Axial length (AL): 23 mm: 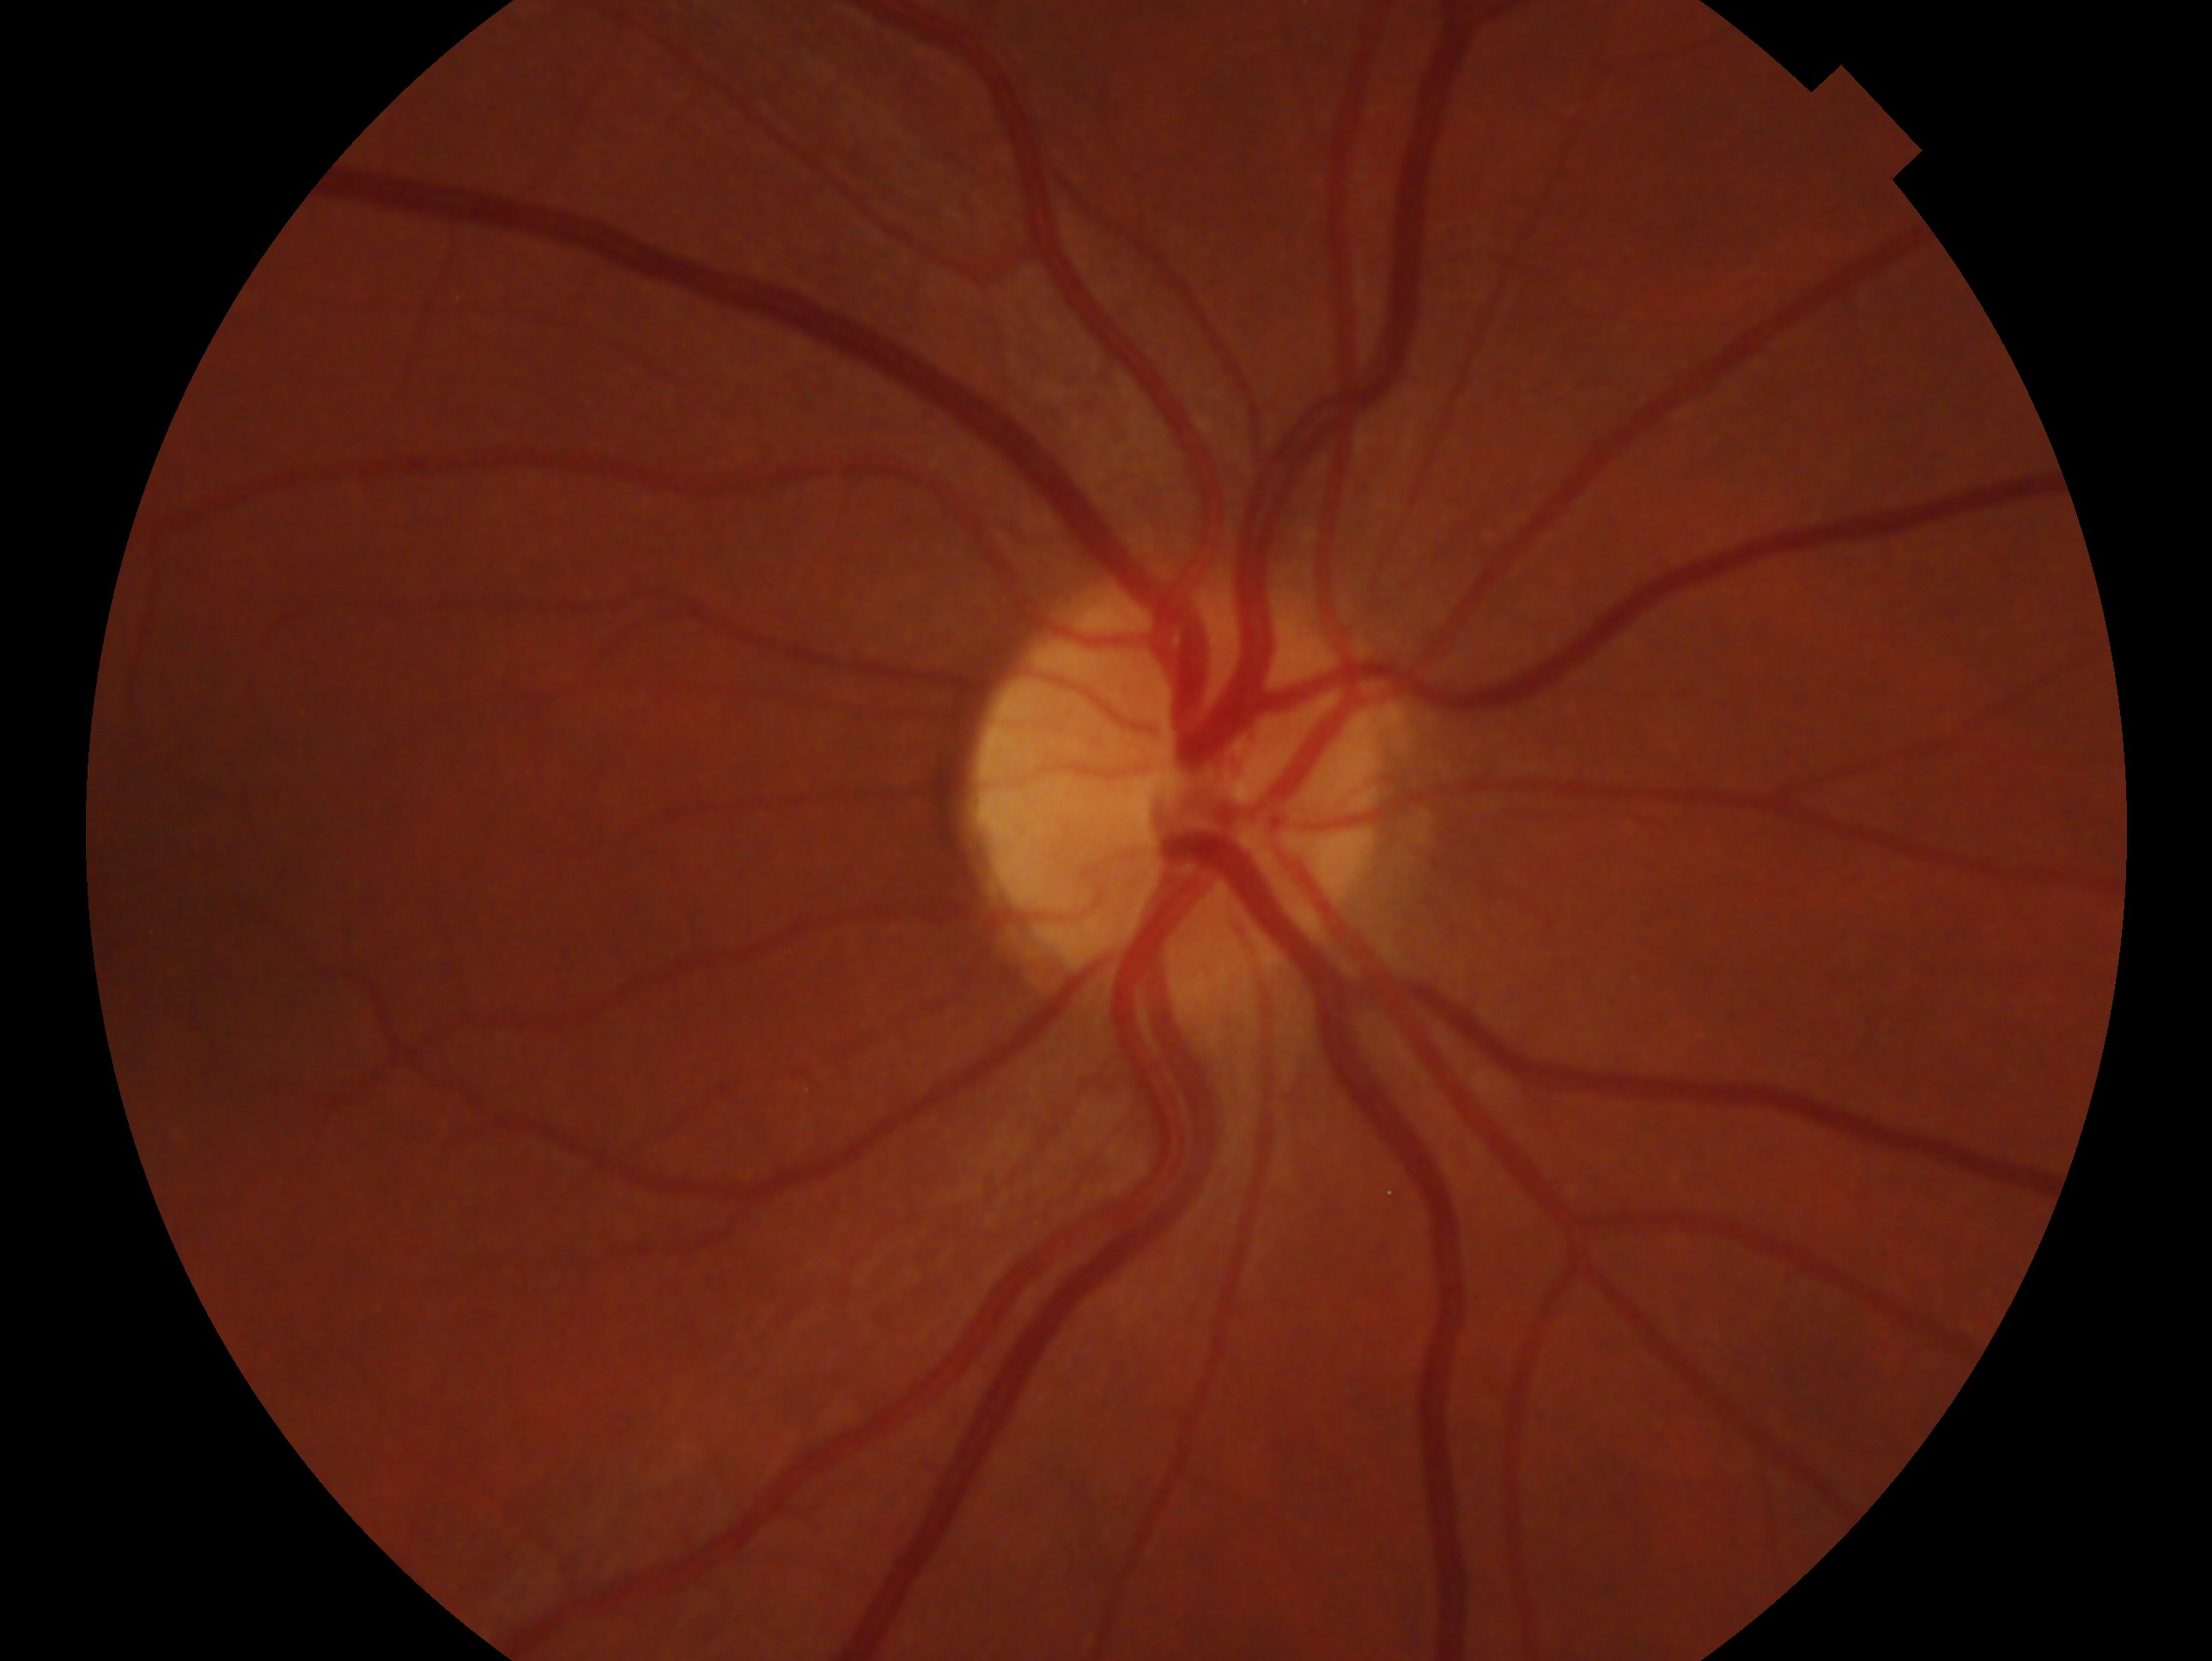
impression = no glaucomatous findings — no clinical evidence of glaucoma in this eye
laterality = right